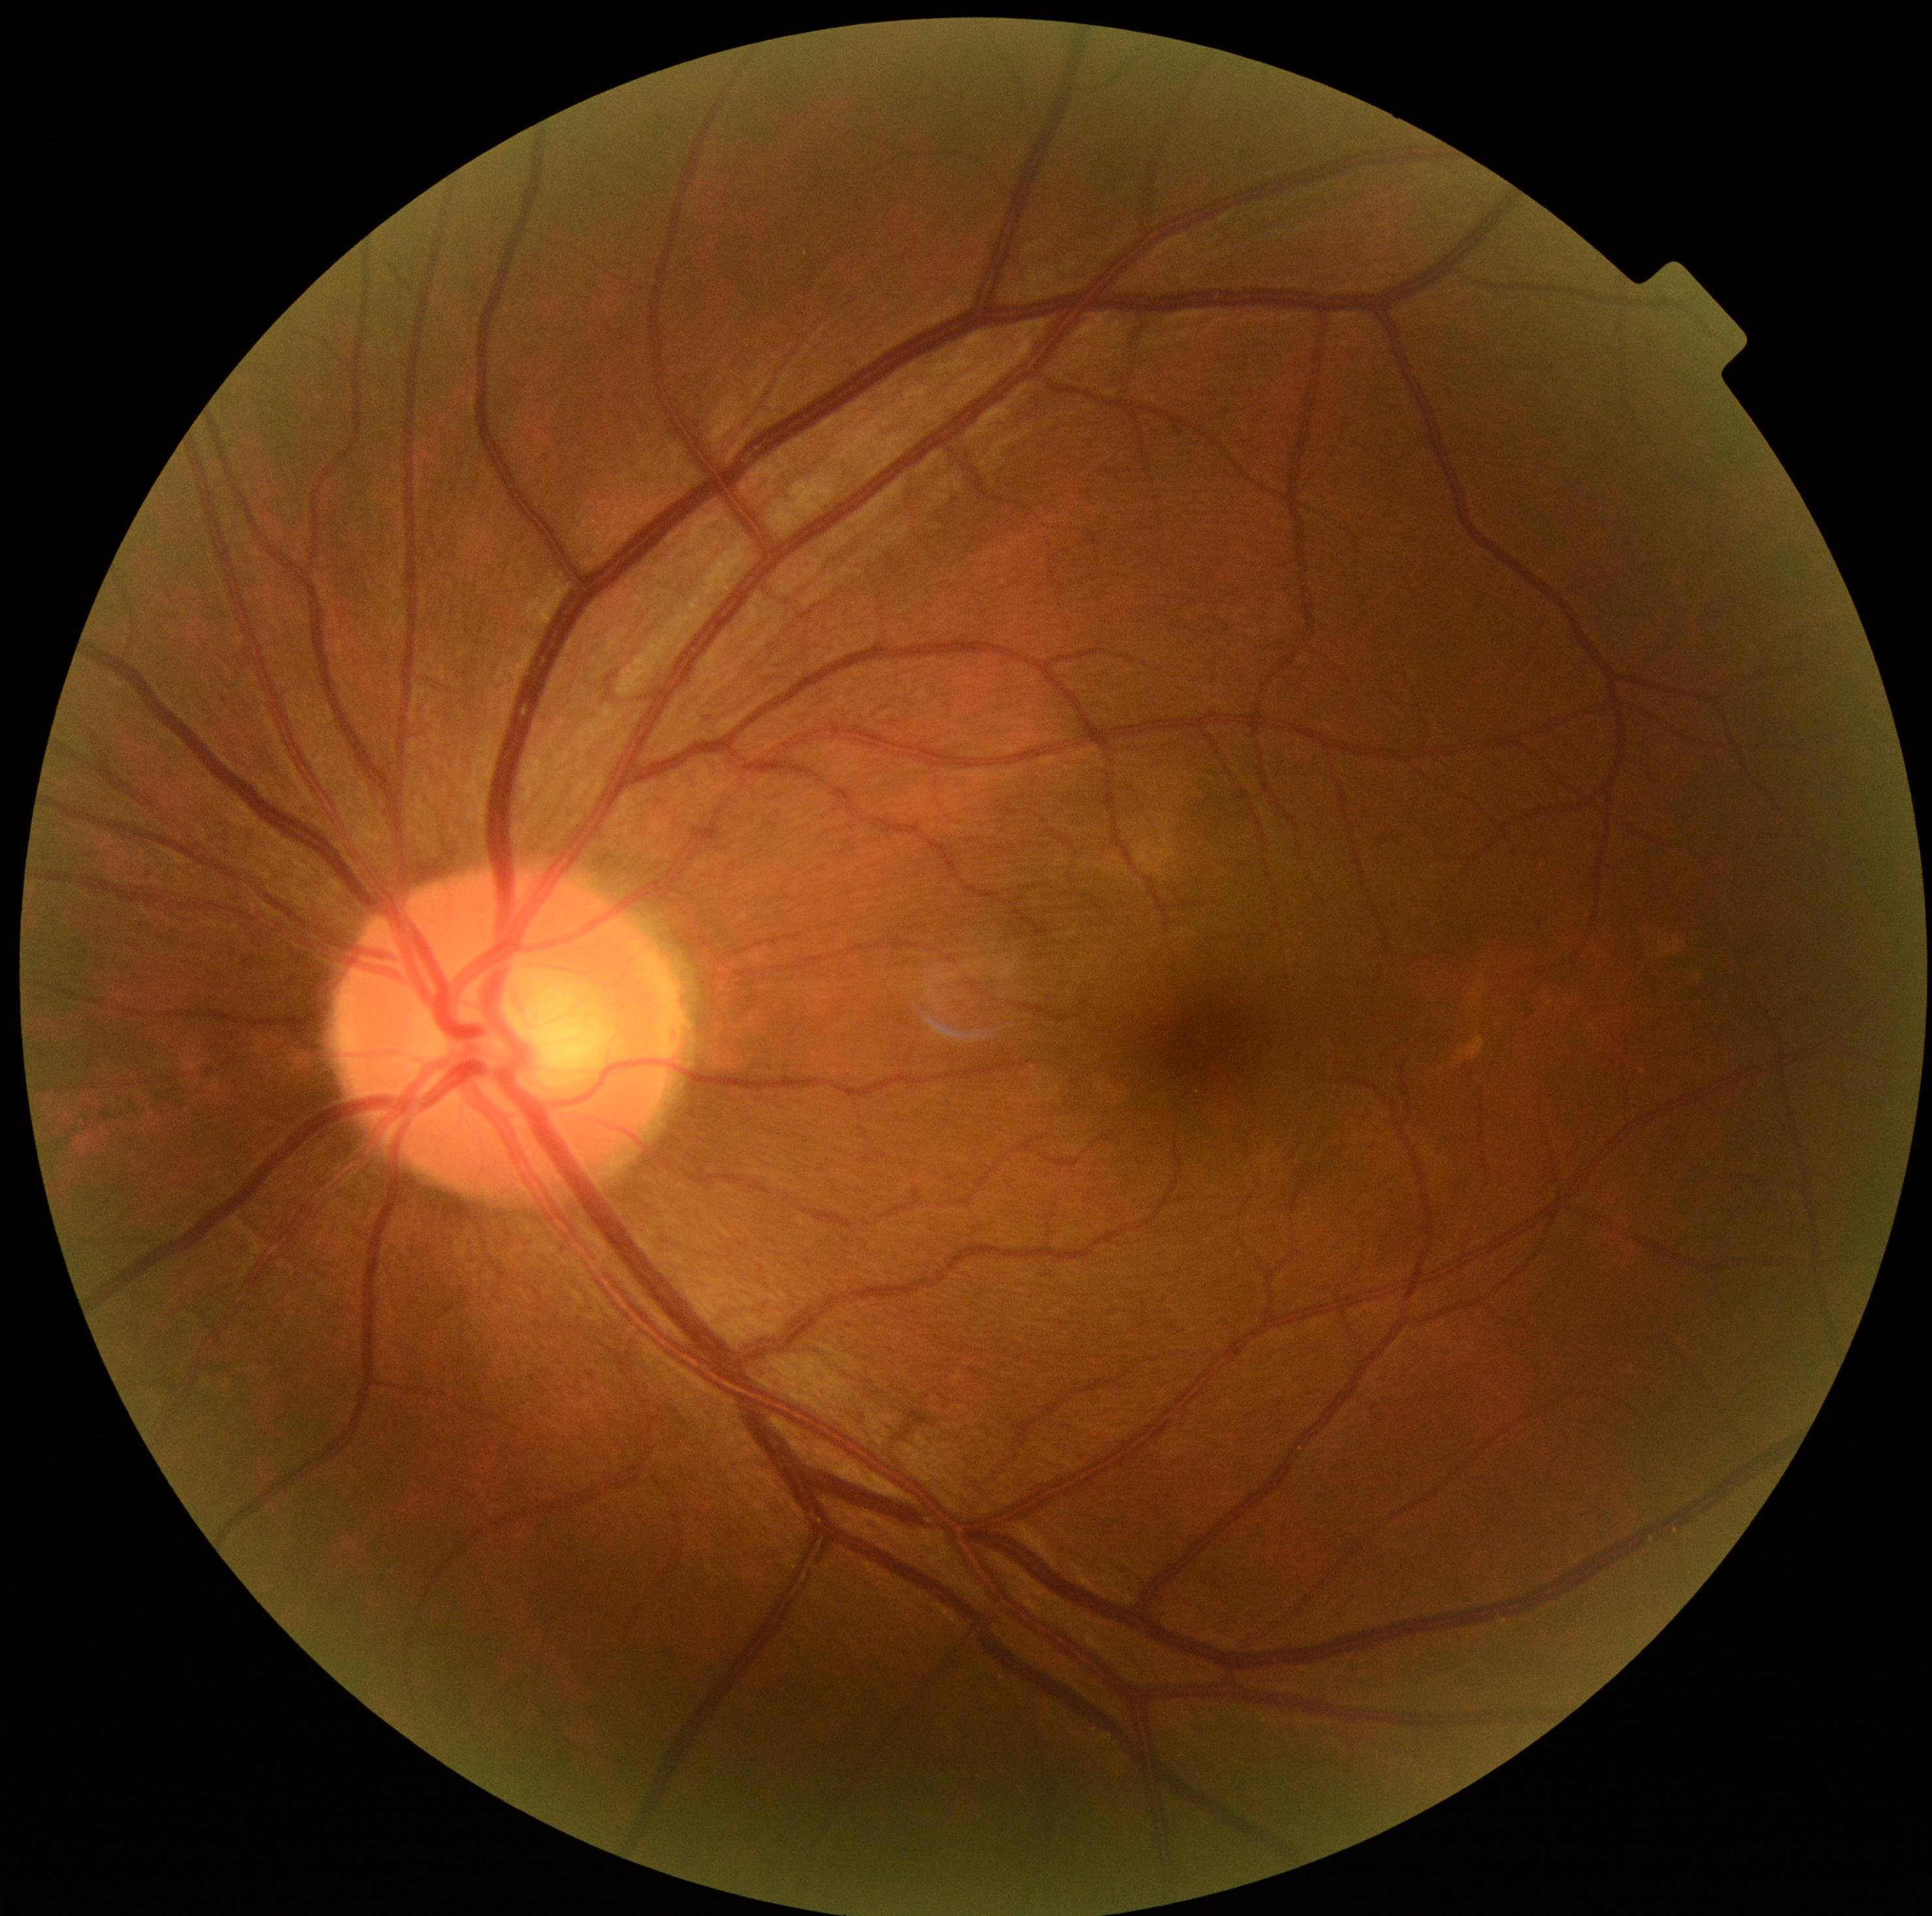
DR stage: 0